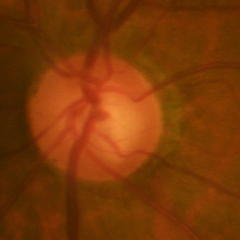 Early glaucoma.